Pediatric retinal photograph (wide-field). 640x480:
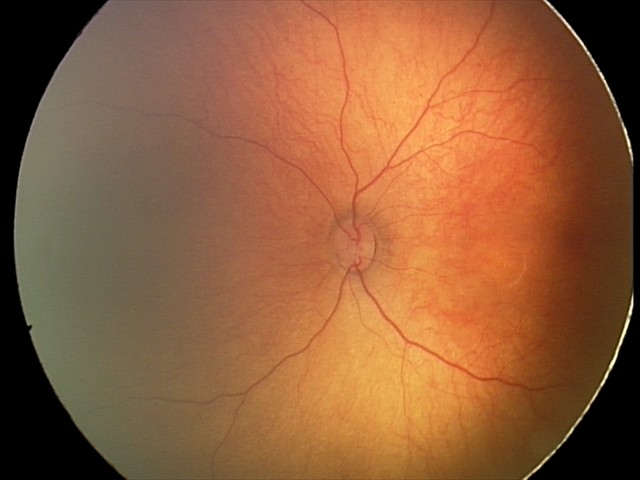
Physiological retinal appearance for postconceptual age.